Optic disc-centered crop.
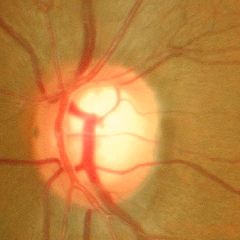 Early glaucomatous optic neuropathy.